Without pupil dilation; NIDEK AFC-230 — 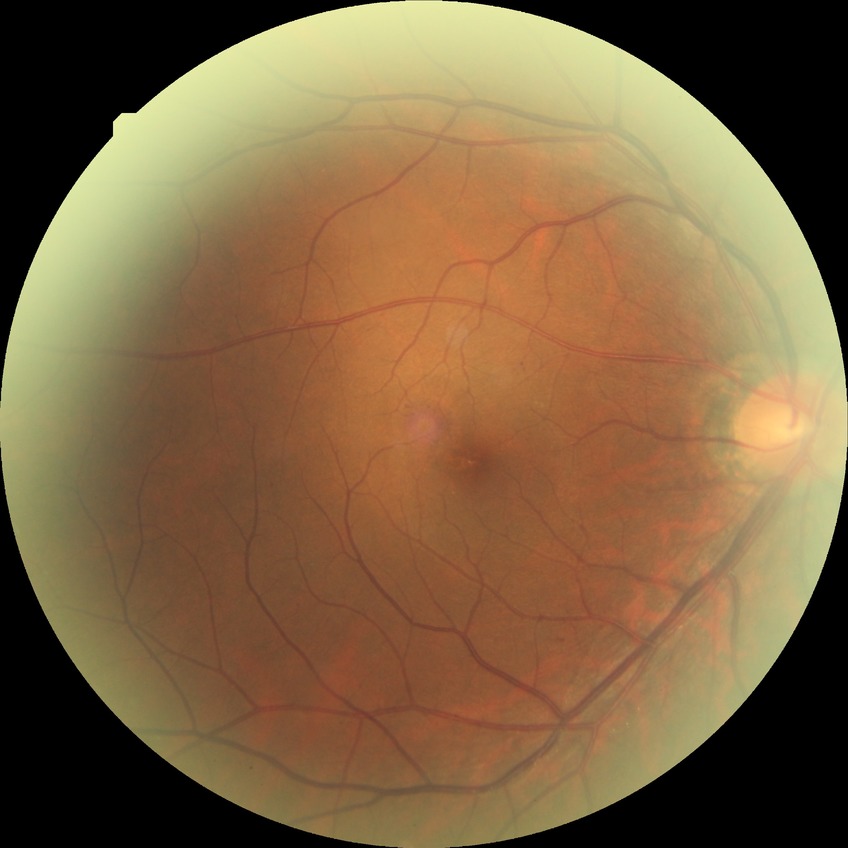
  davis_grade: SDR (simple diabetic retinopathy)